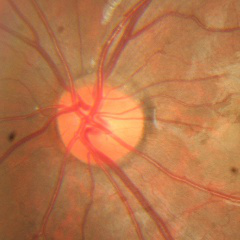
Optic nerve head appearance consistent with no evidence of glaucoma.